Diabetic retinopathy graded by the modified Davis classification · FOV: 45 degrees · no pharmacologic dilation · acquired with a NIDEK AFC-230: 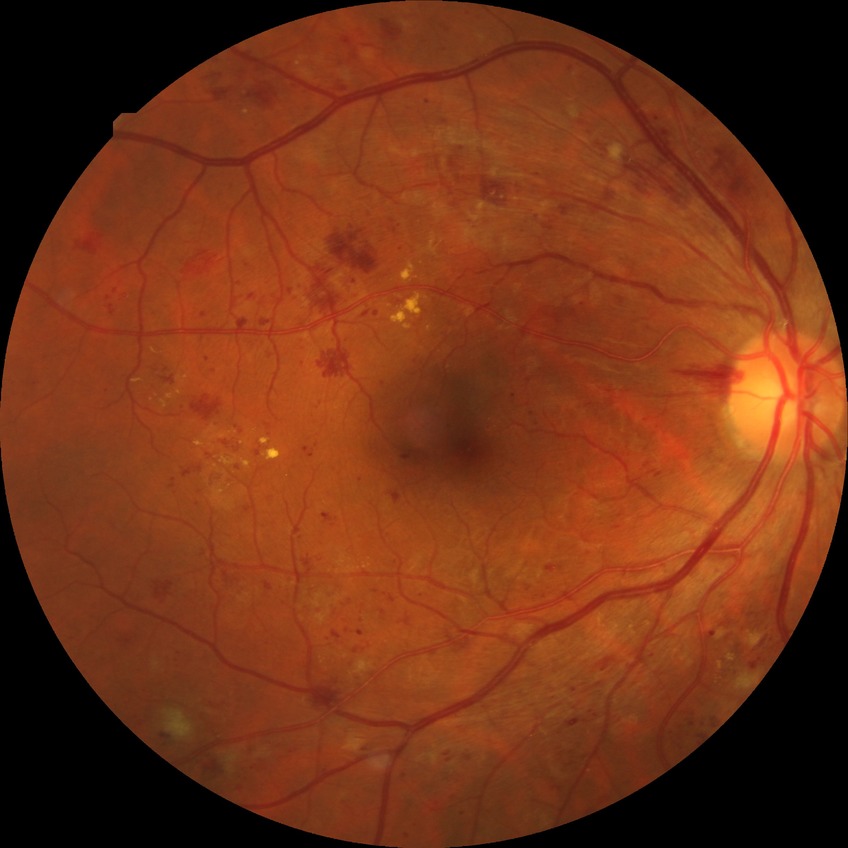

Diabetic retinopathy (DR): pre-proliferative diabetic retinopathy (PPDR).